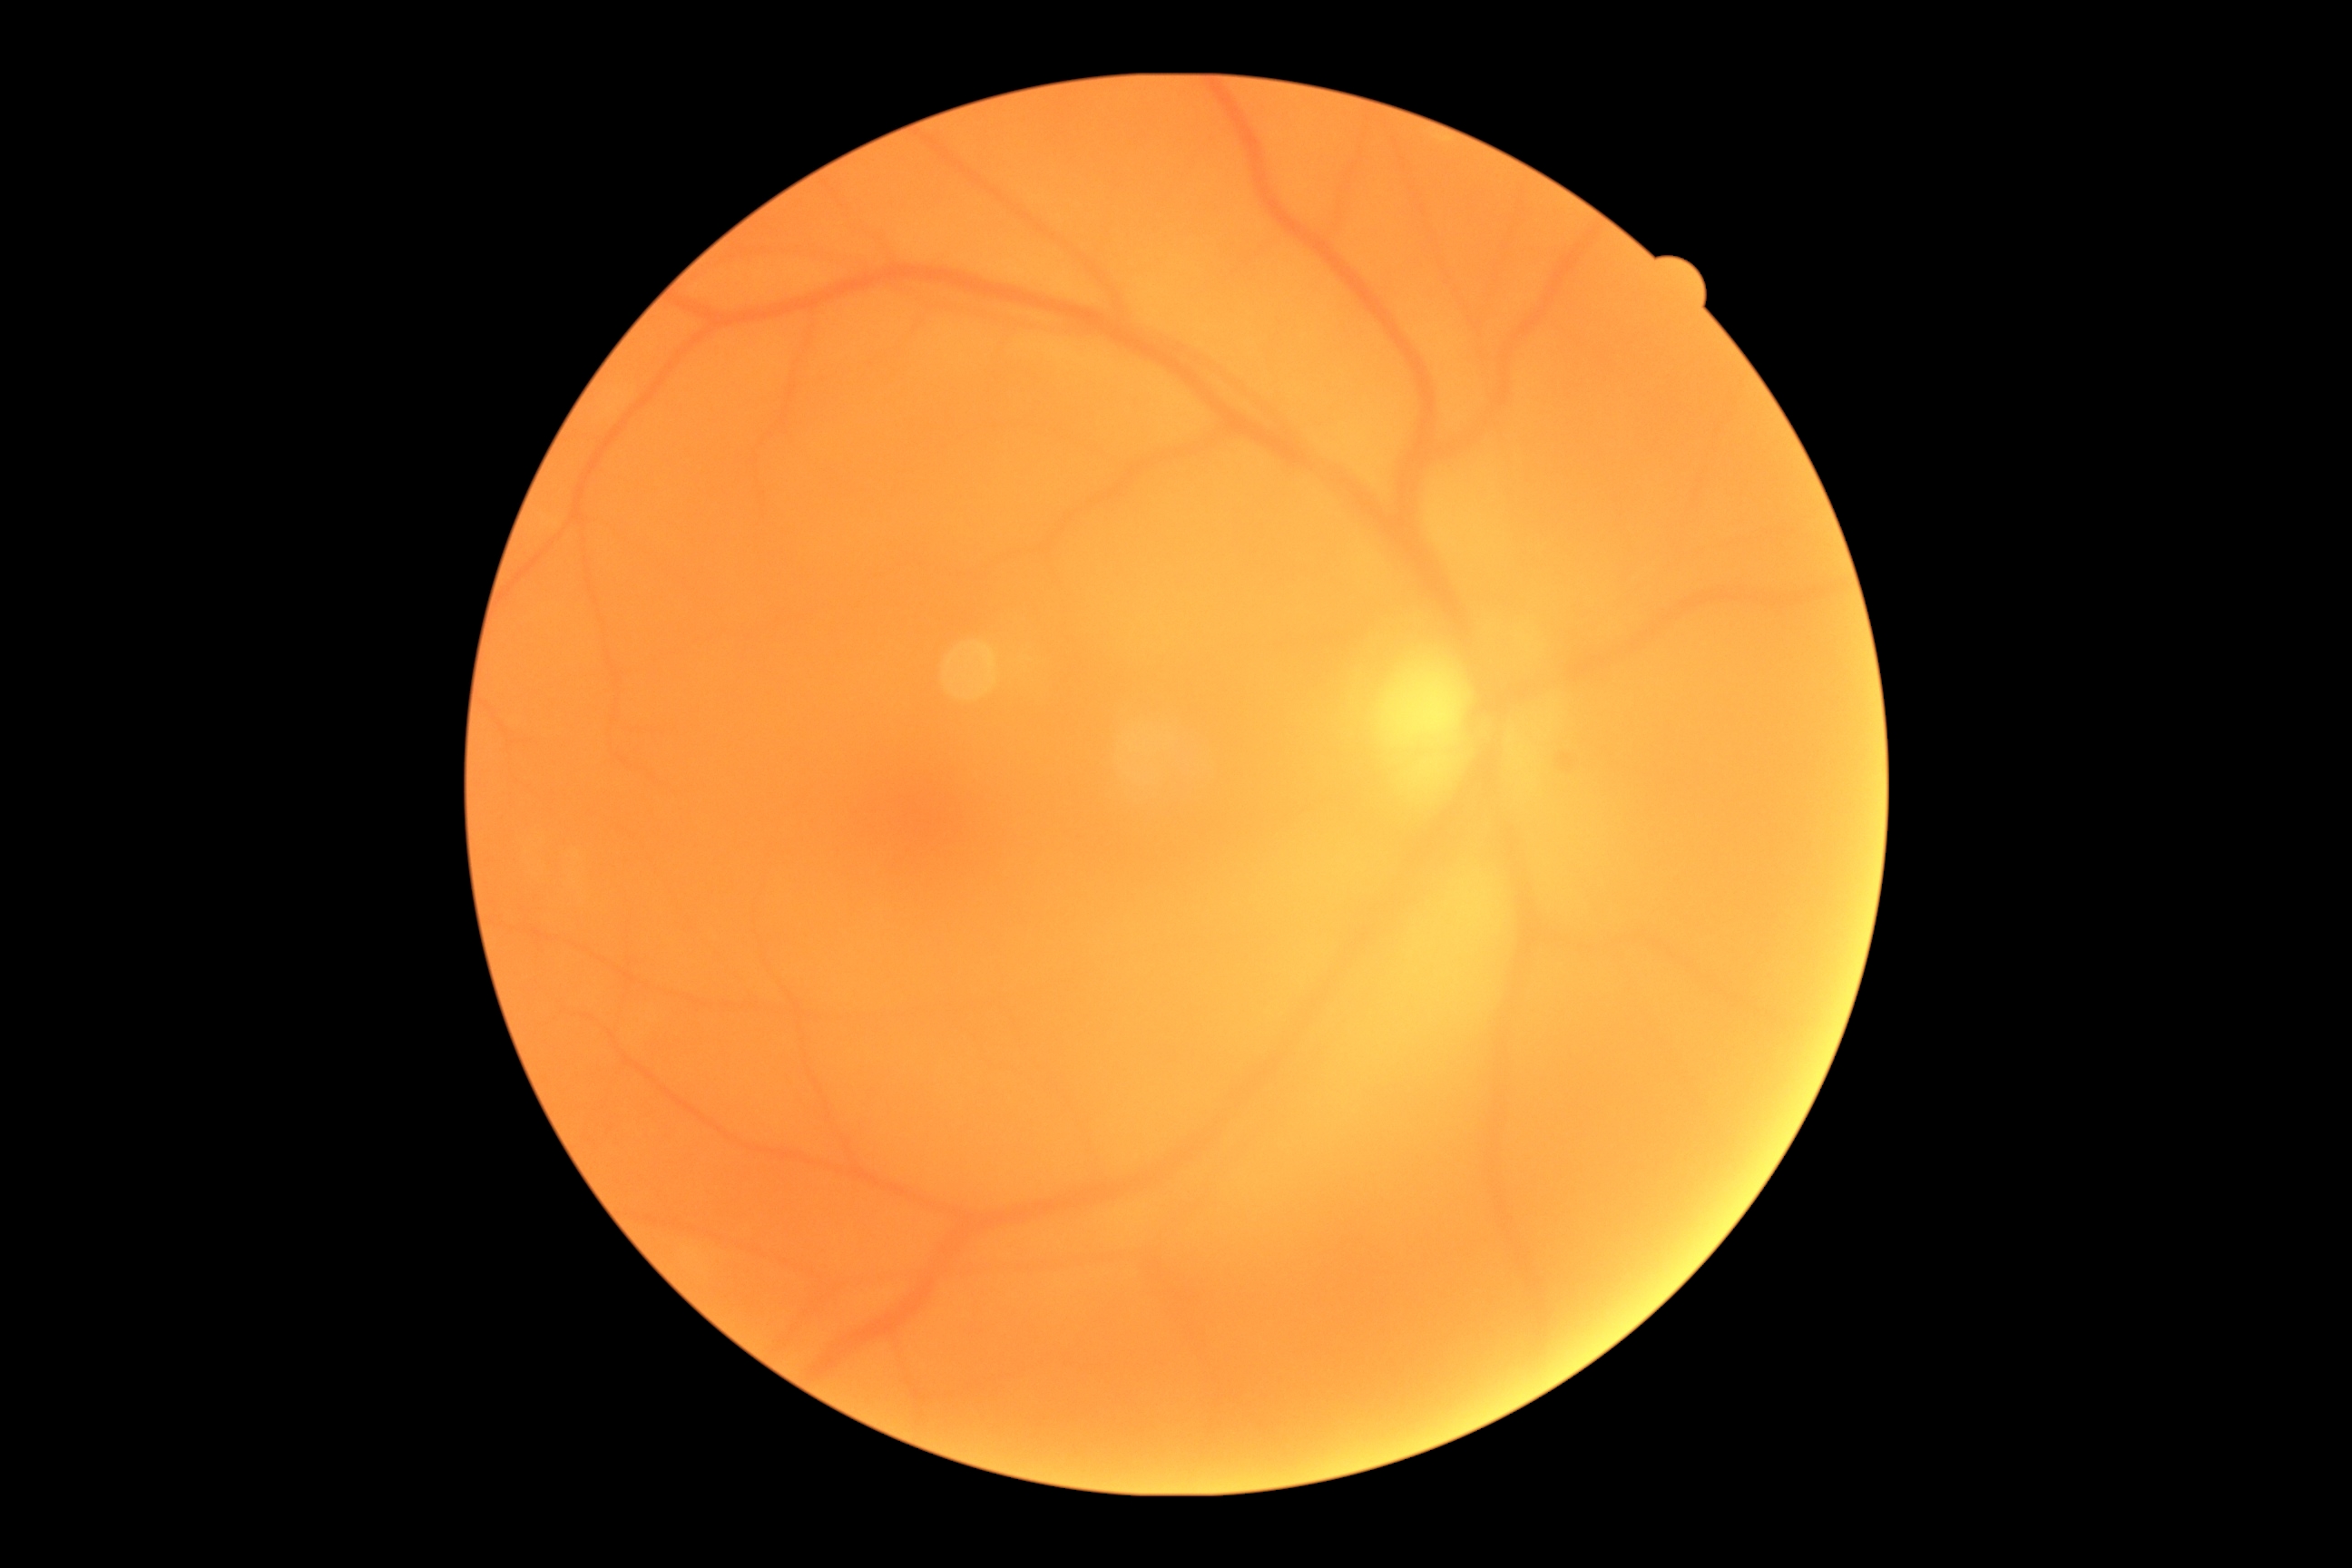
DR severity = 0.